UWF retinal mosaic — 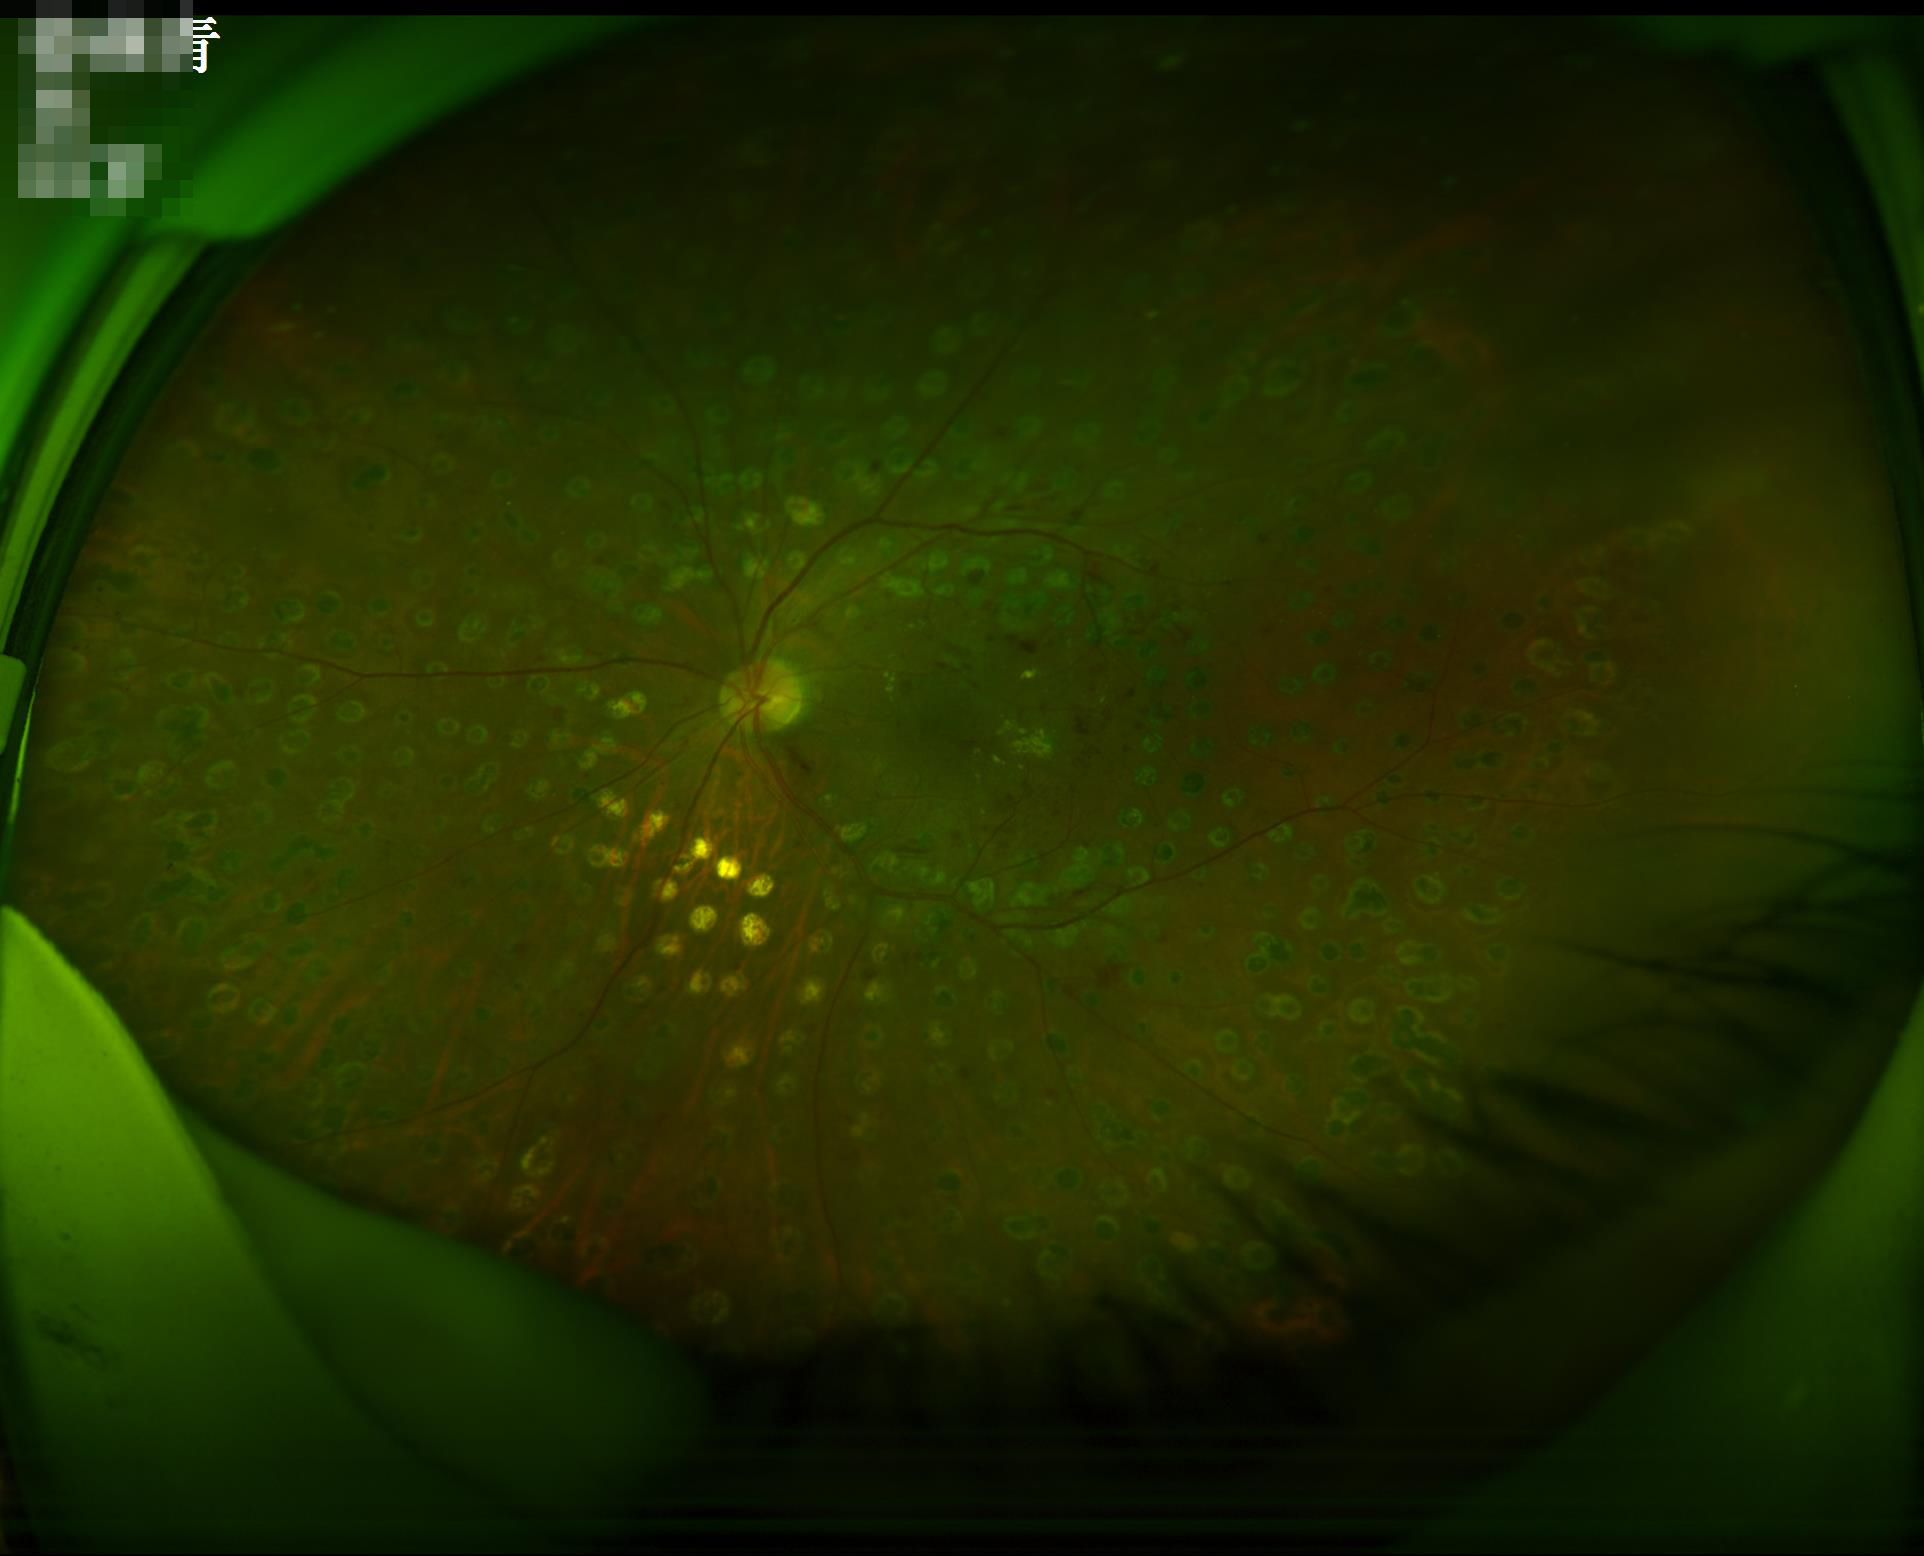 There is over- or under-exposure or a color cast. Image quality is adequate for diagnostic use. Vessels and details are readily distinguishable. No noticeable blur.